Portable fundus photograph
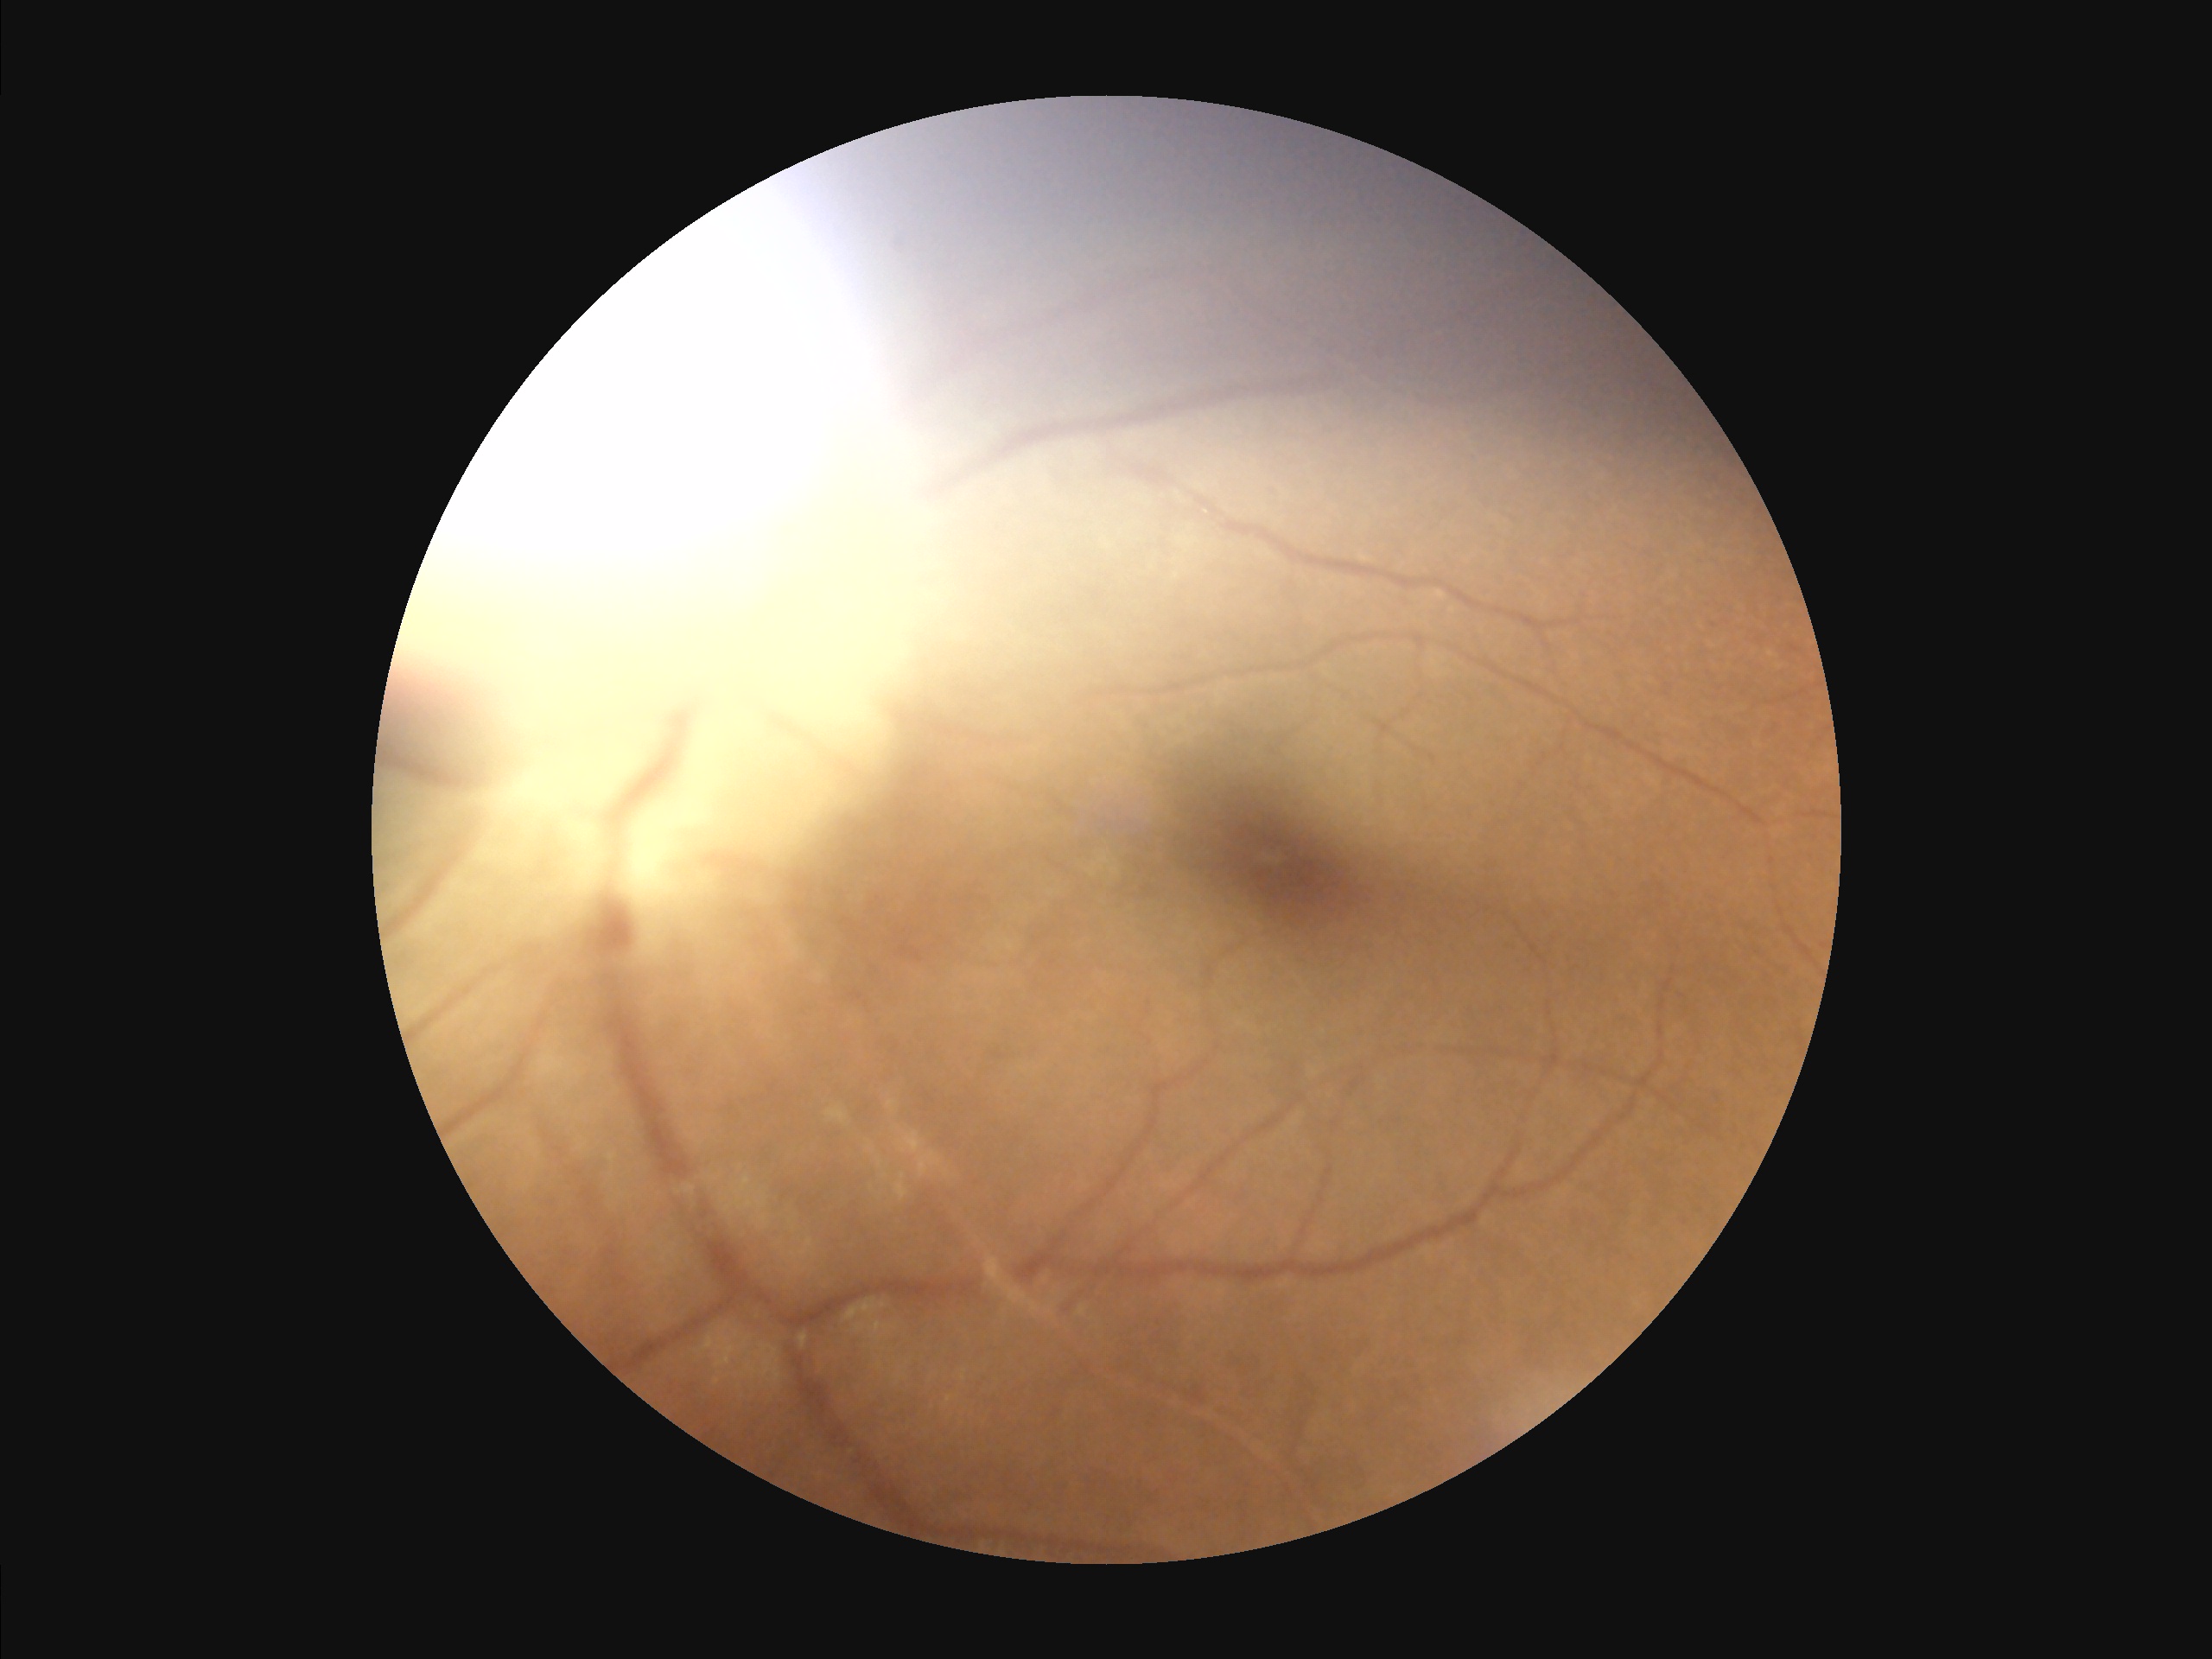   clarity: out of focus, structures indistinct
  illumination: uneven illumination or color cast
  overall_quality: inadequate for clinical interpretation
  contrast: narrow intensity range, structures hard to distinguish